Fundus photo — 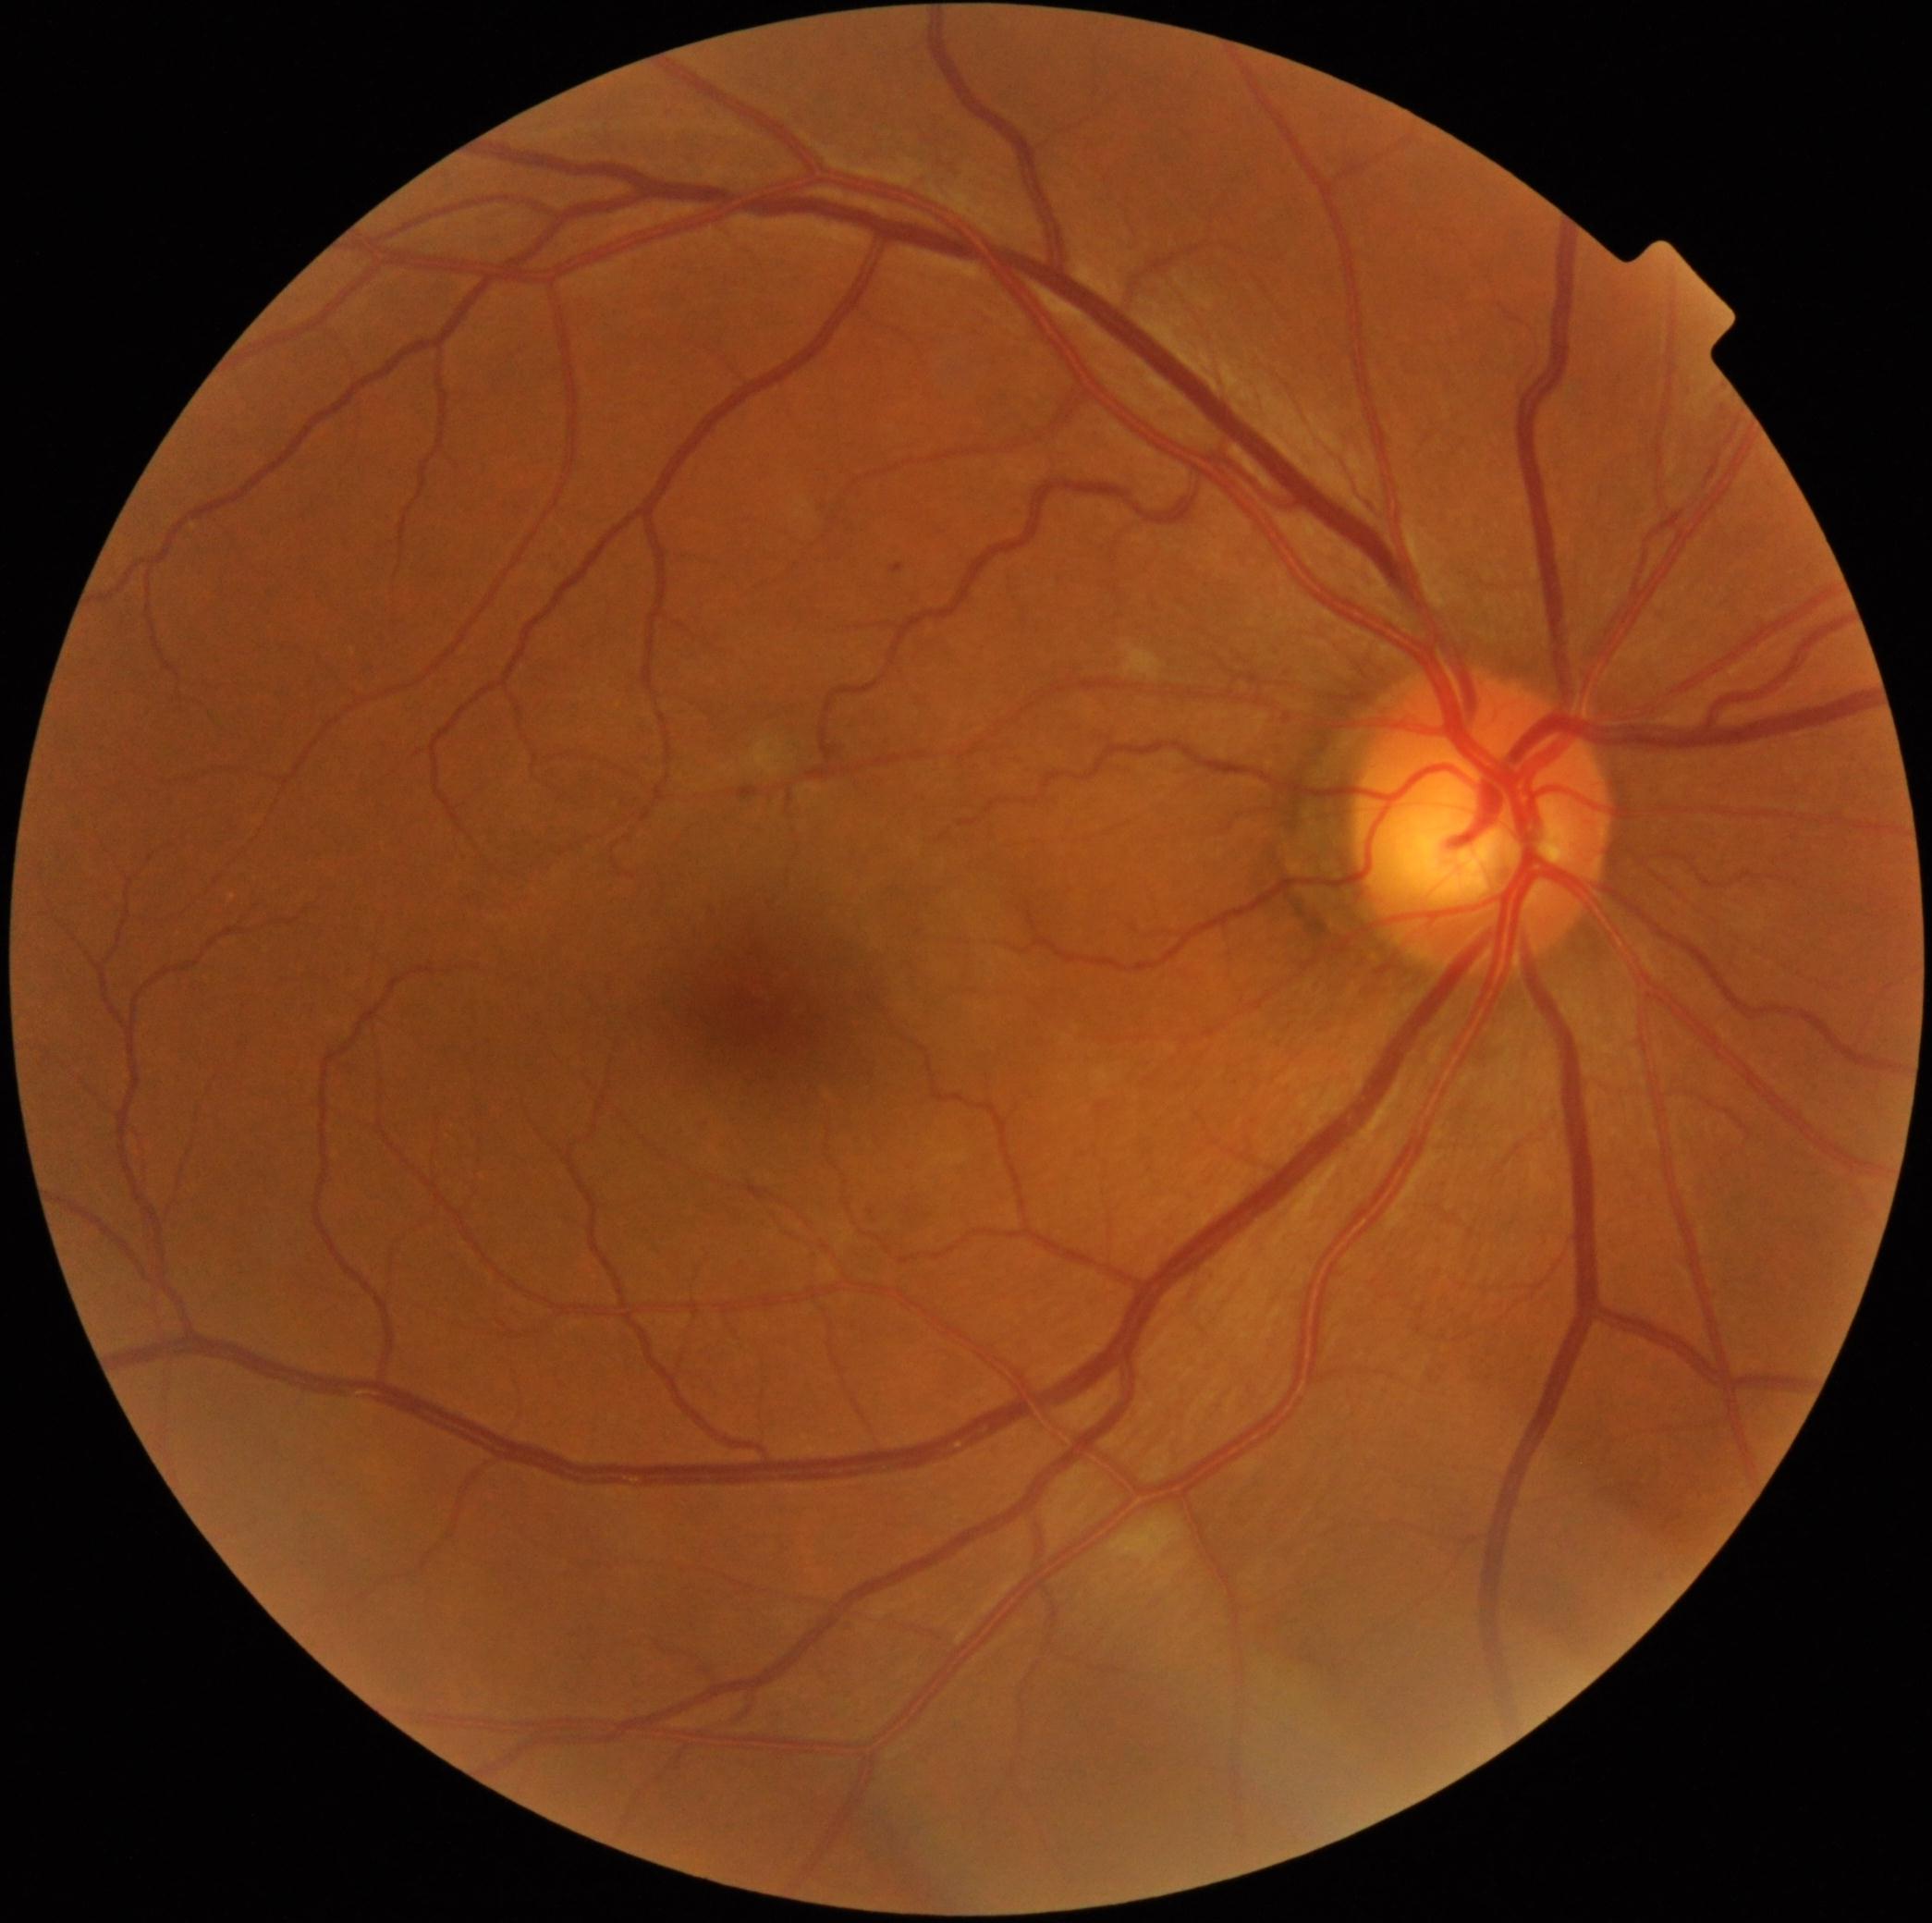 DR class = non-proliferative diabetic retinopathy
DR grade = 2 (moderate NPDR)